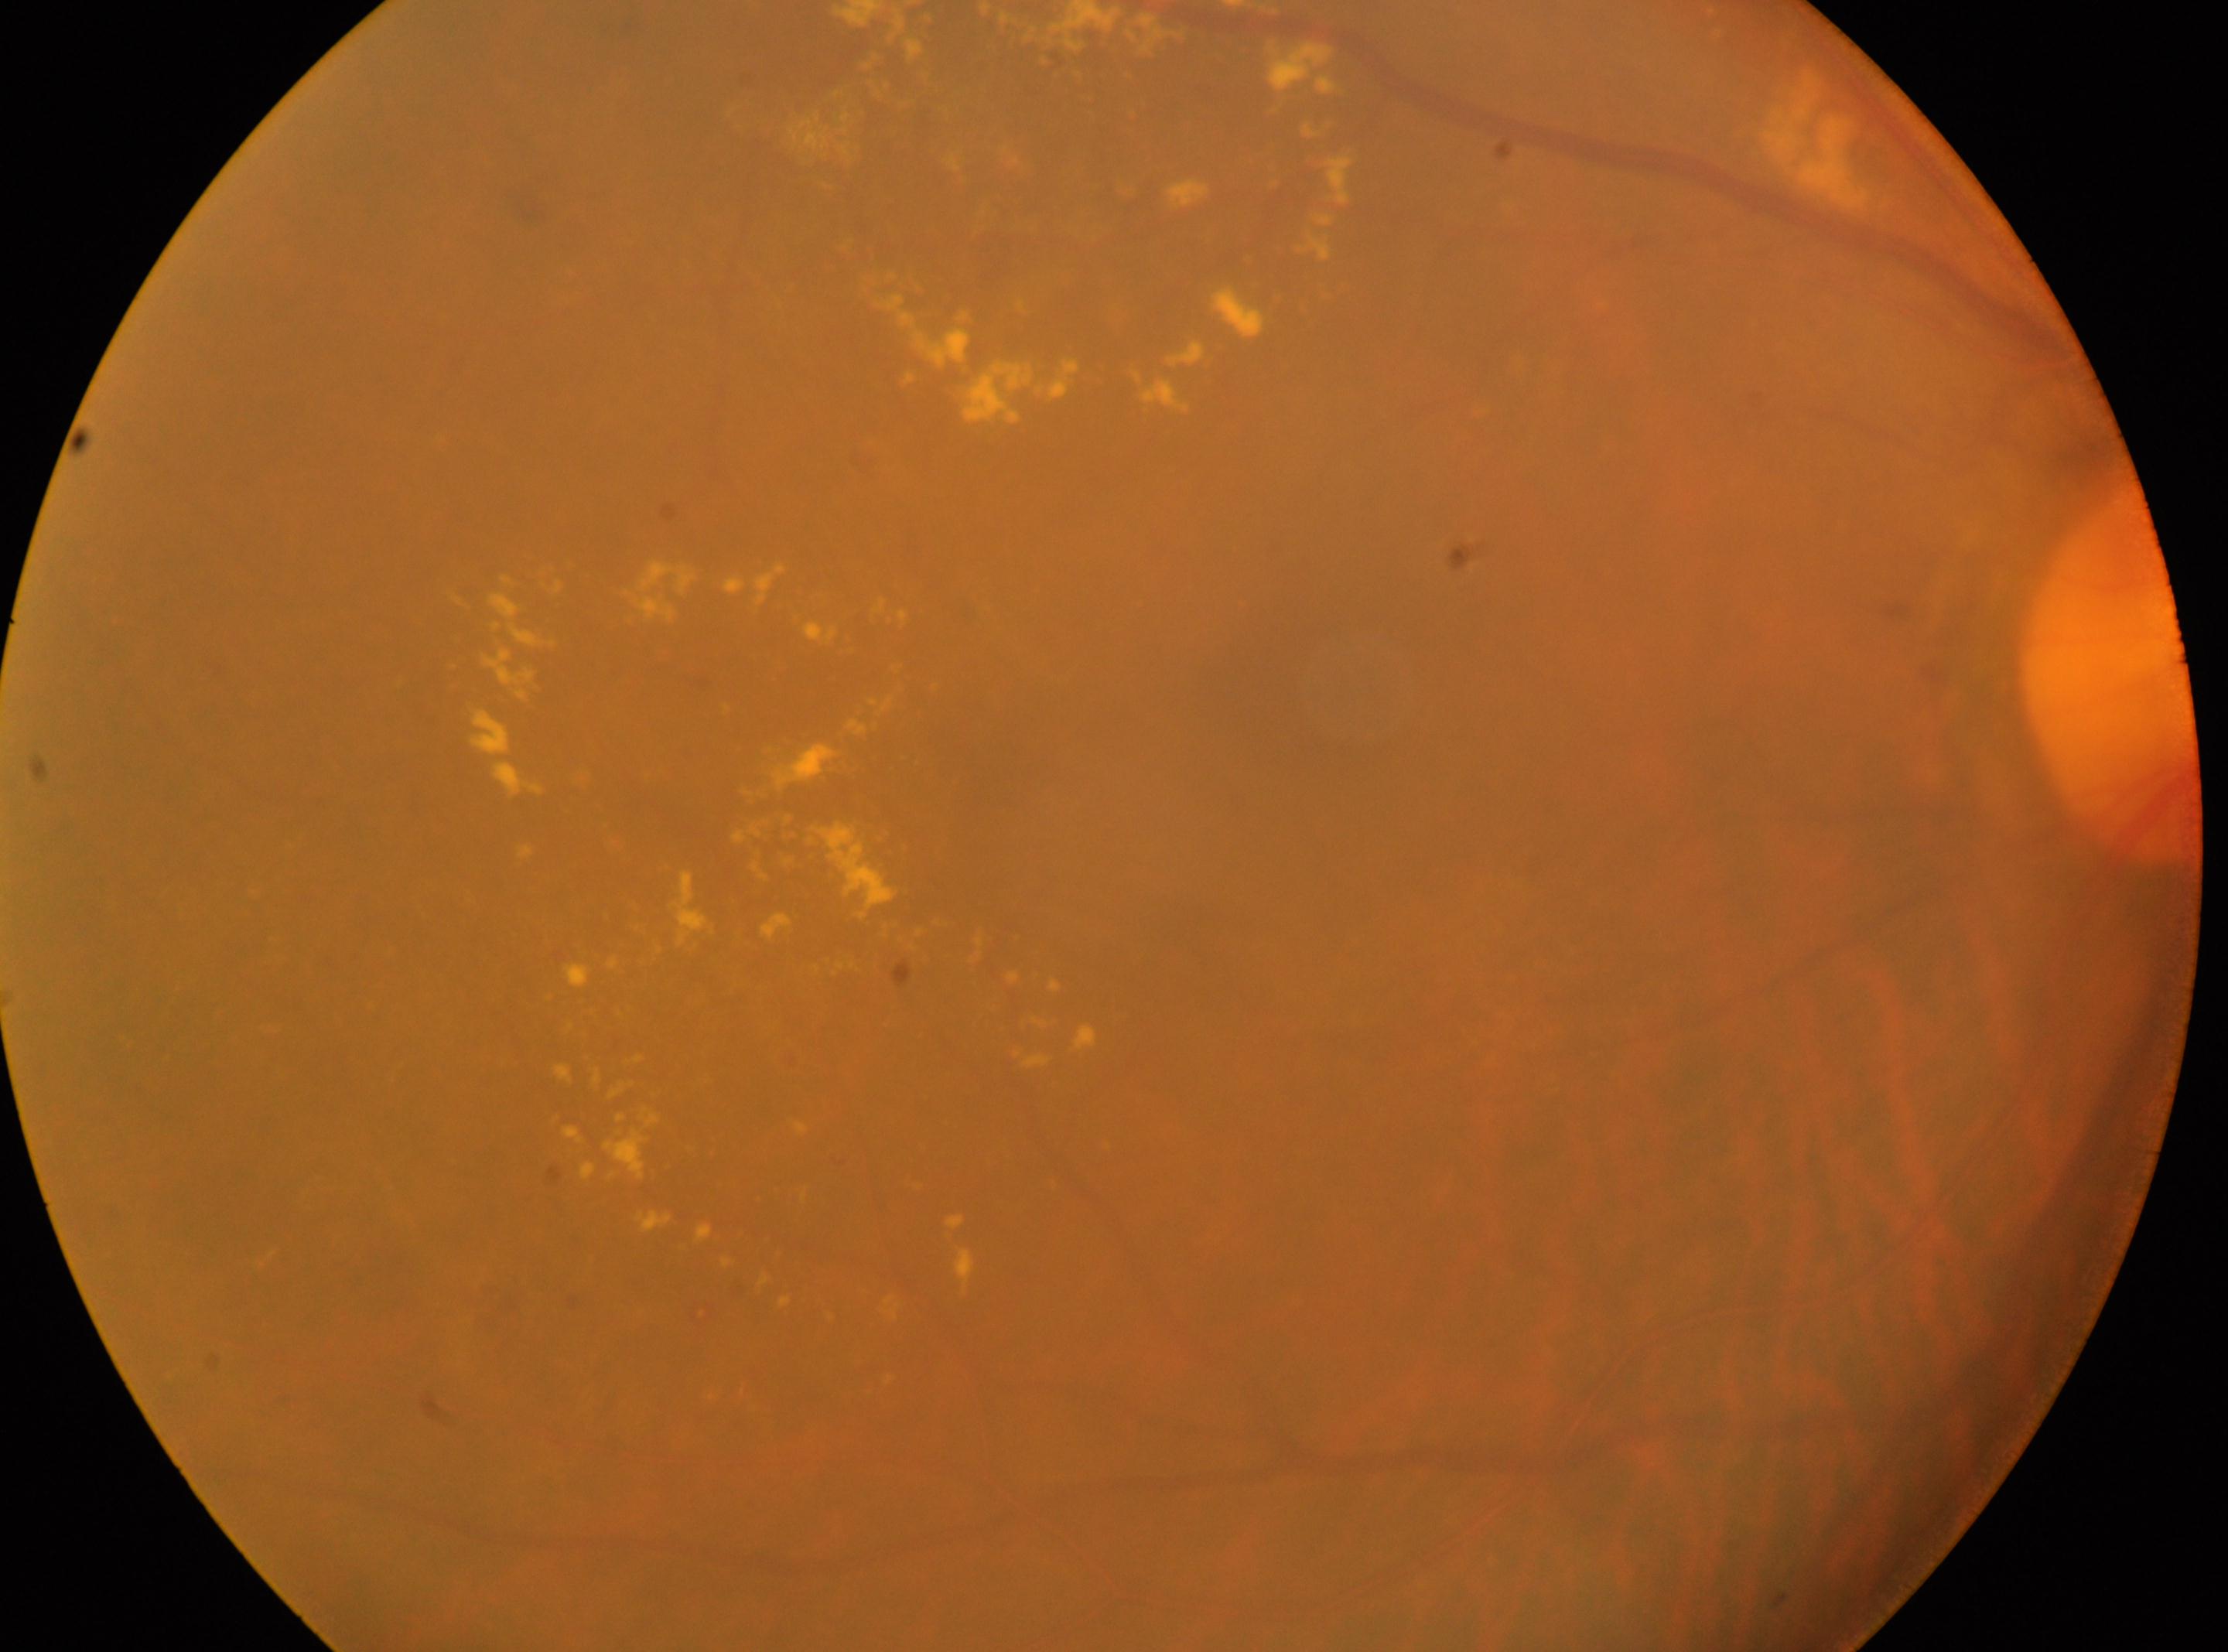

* laterality · right eye
* foveal center · x=1298, y=716
* optic disk · x=2112, y=673
* DR stage · 2/4
* DR class · non-proliferative diabetic retinopathy